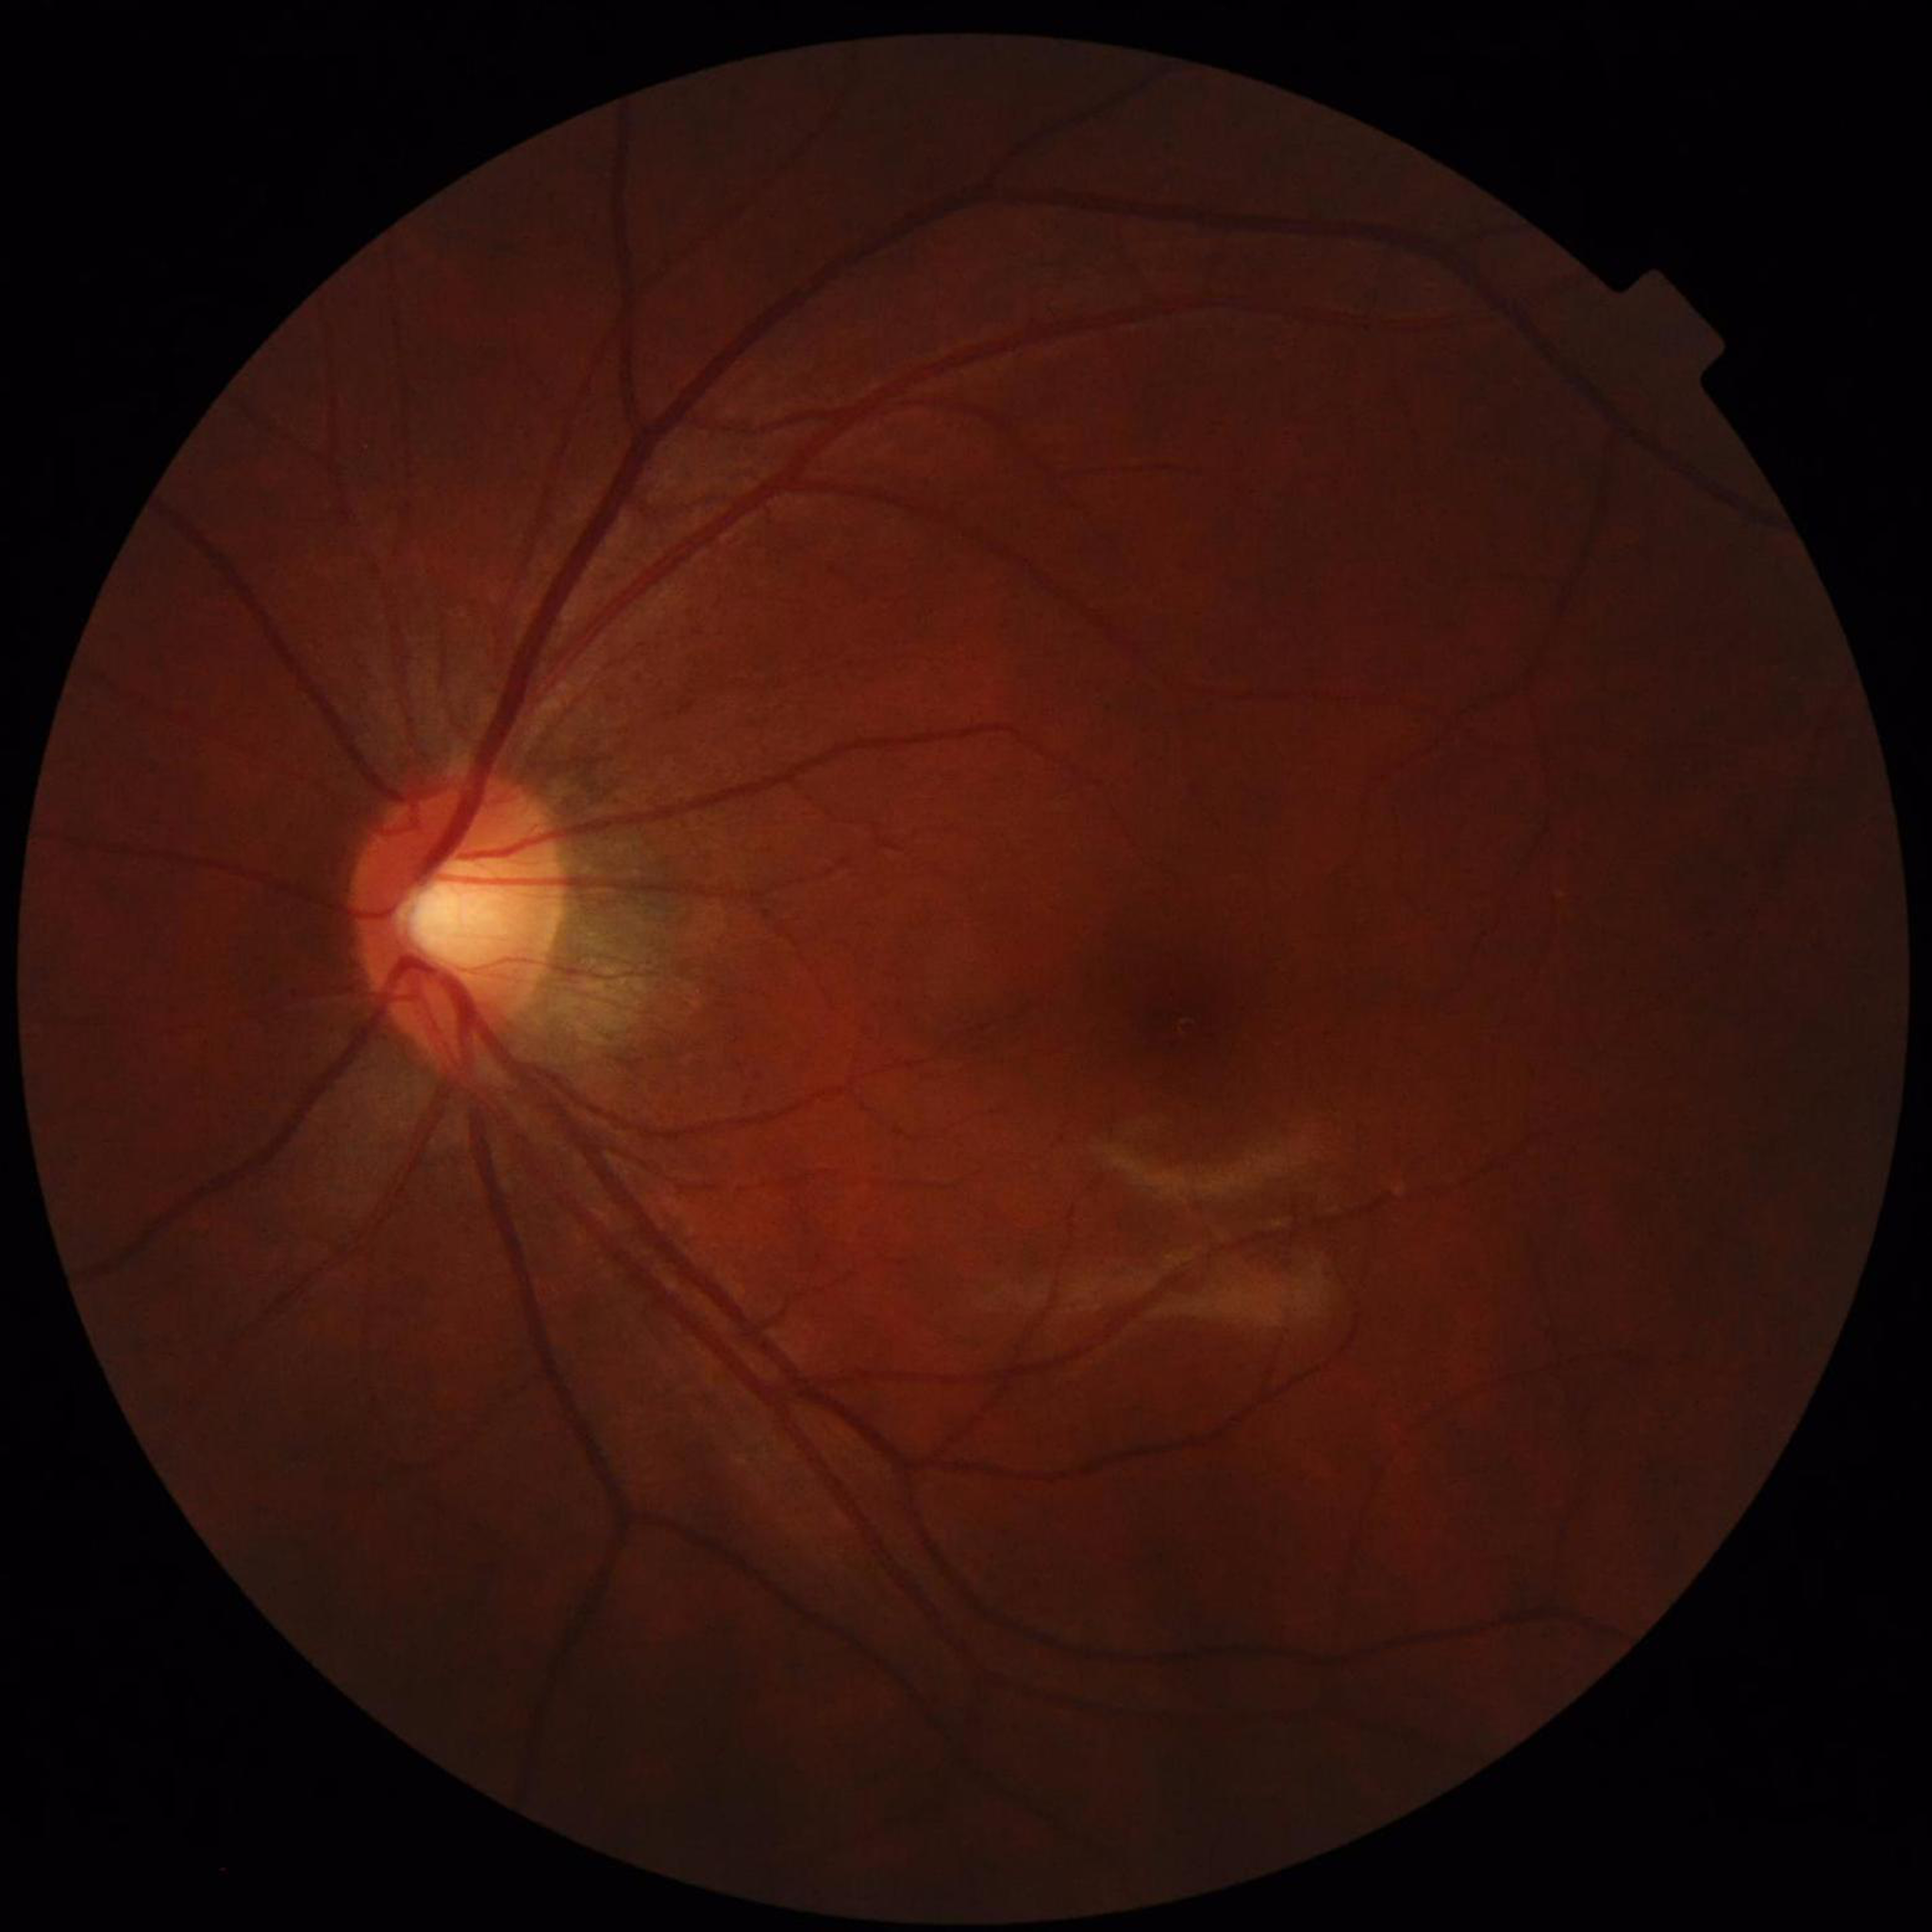 From a patient with glaucoma.
Photo quality: reduced — illumination/color distortion.